2352 x 1568 pixels — 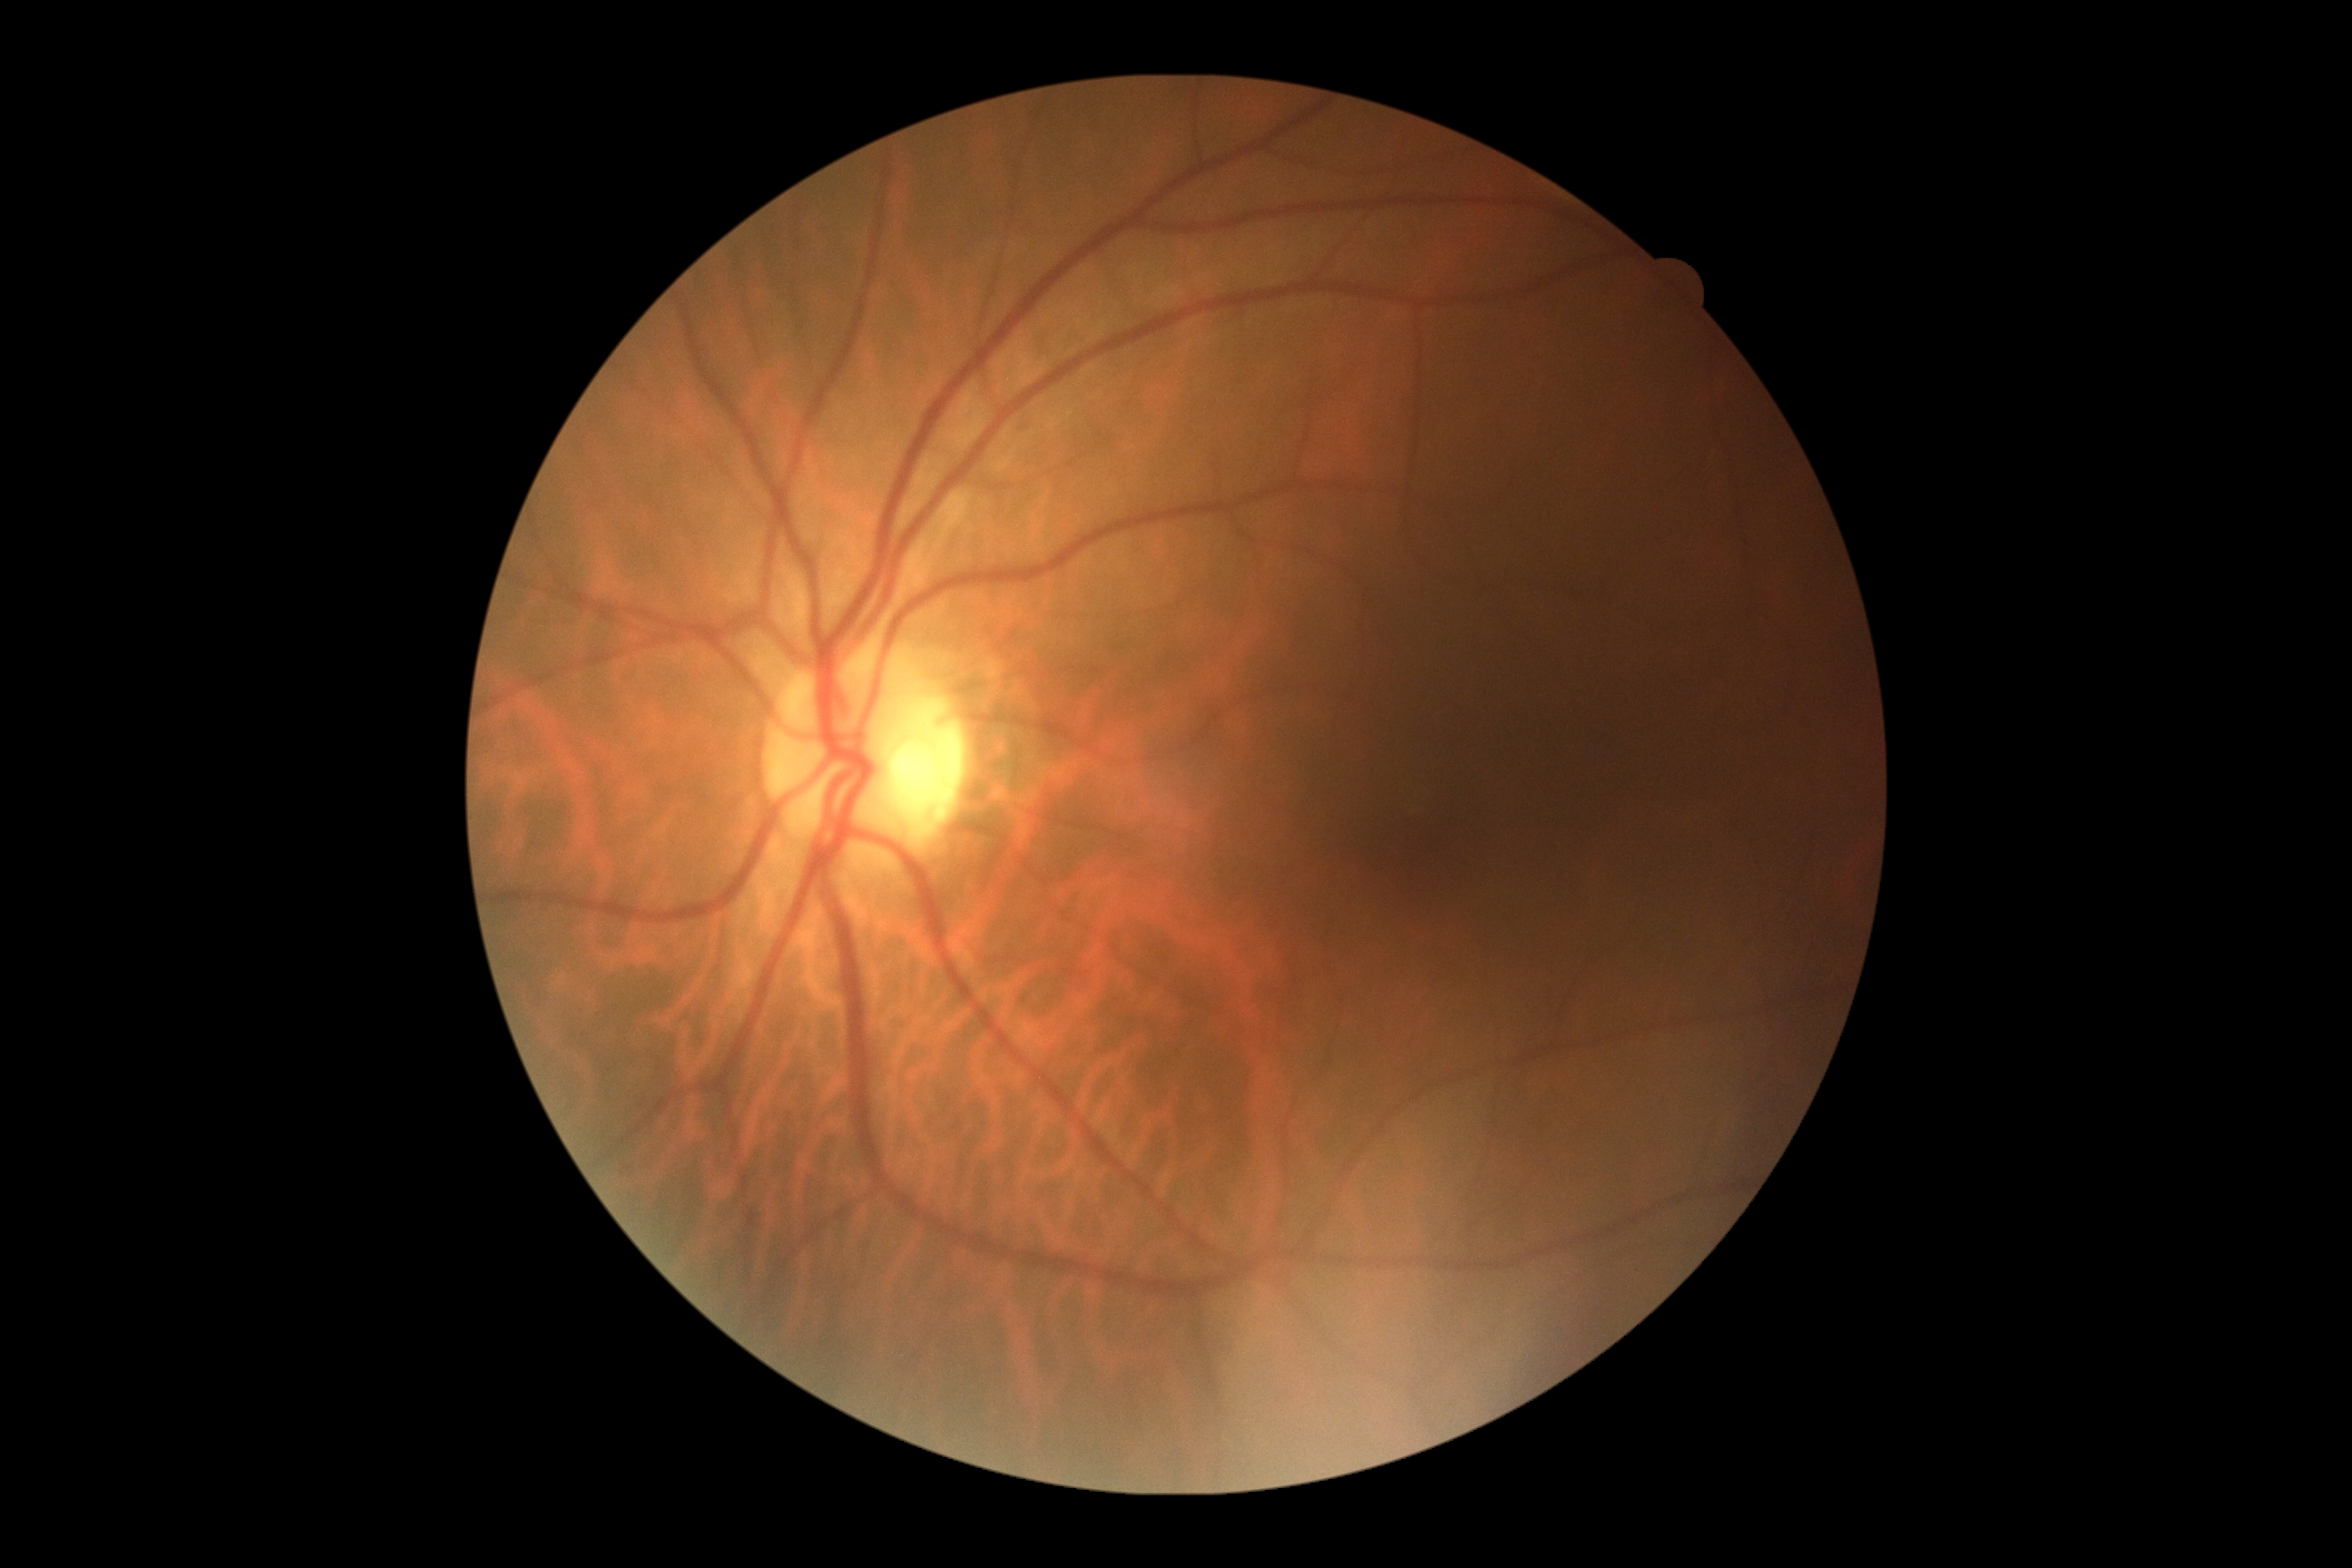

Diabetic retinopathy (DR) is grade 0 (no apparent retinopathy) — no visible signs of diabetic retinopathy.